Without pupil dilation; posterior pole photograph — 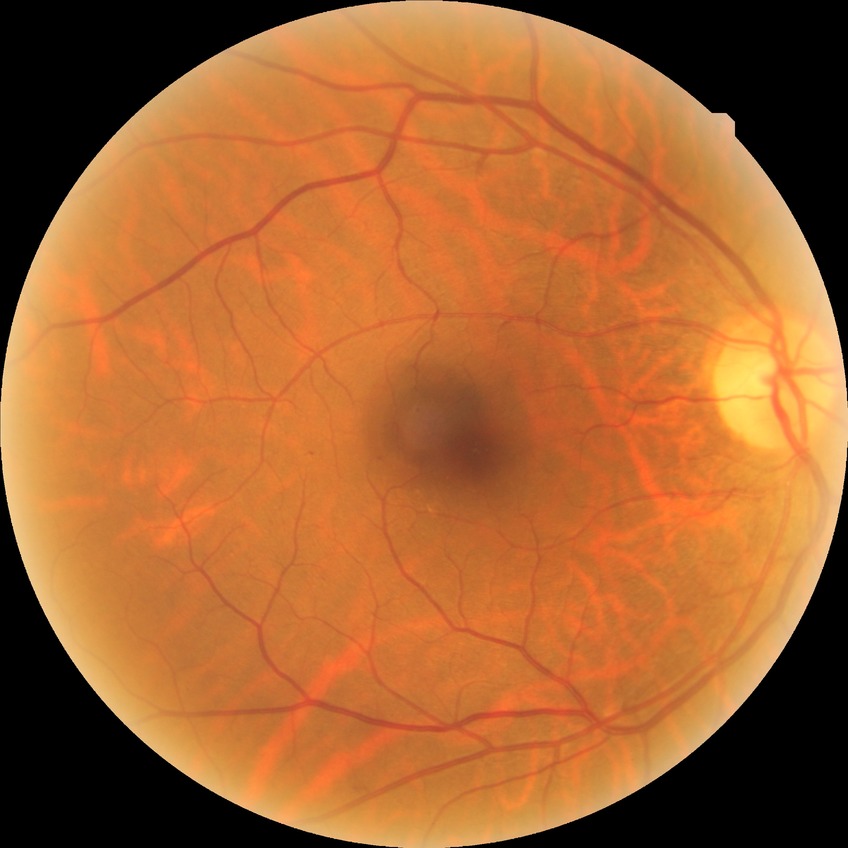 modified Davis grading: simple diabetic retinopathy.